45° FOV: 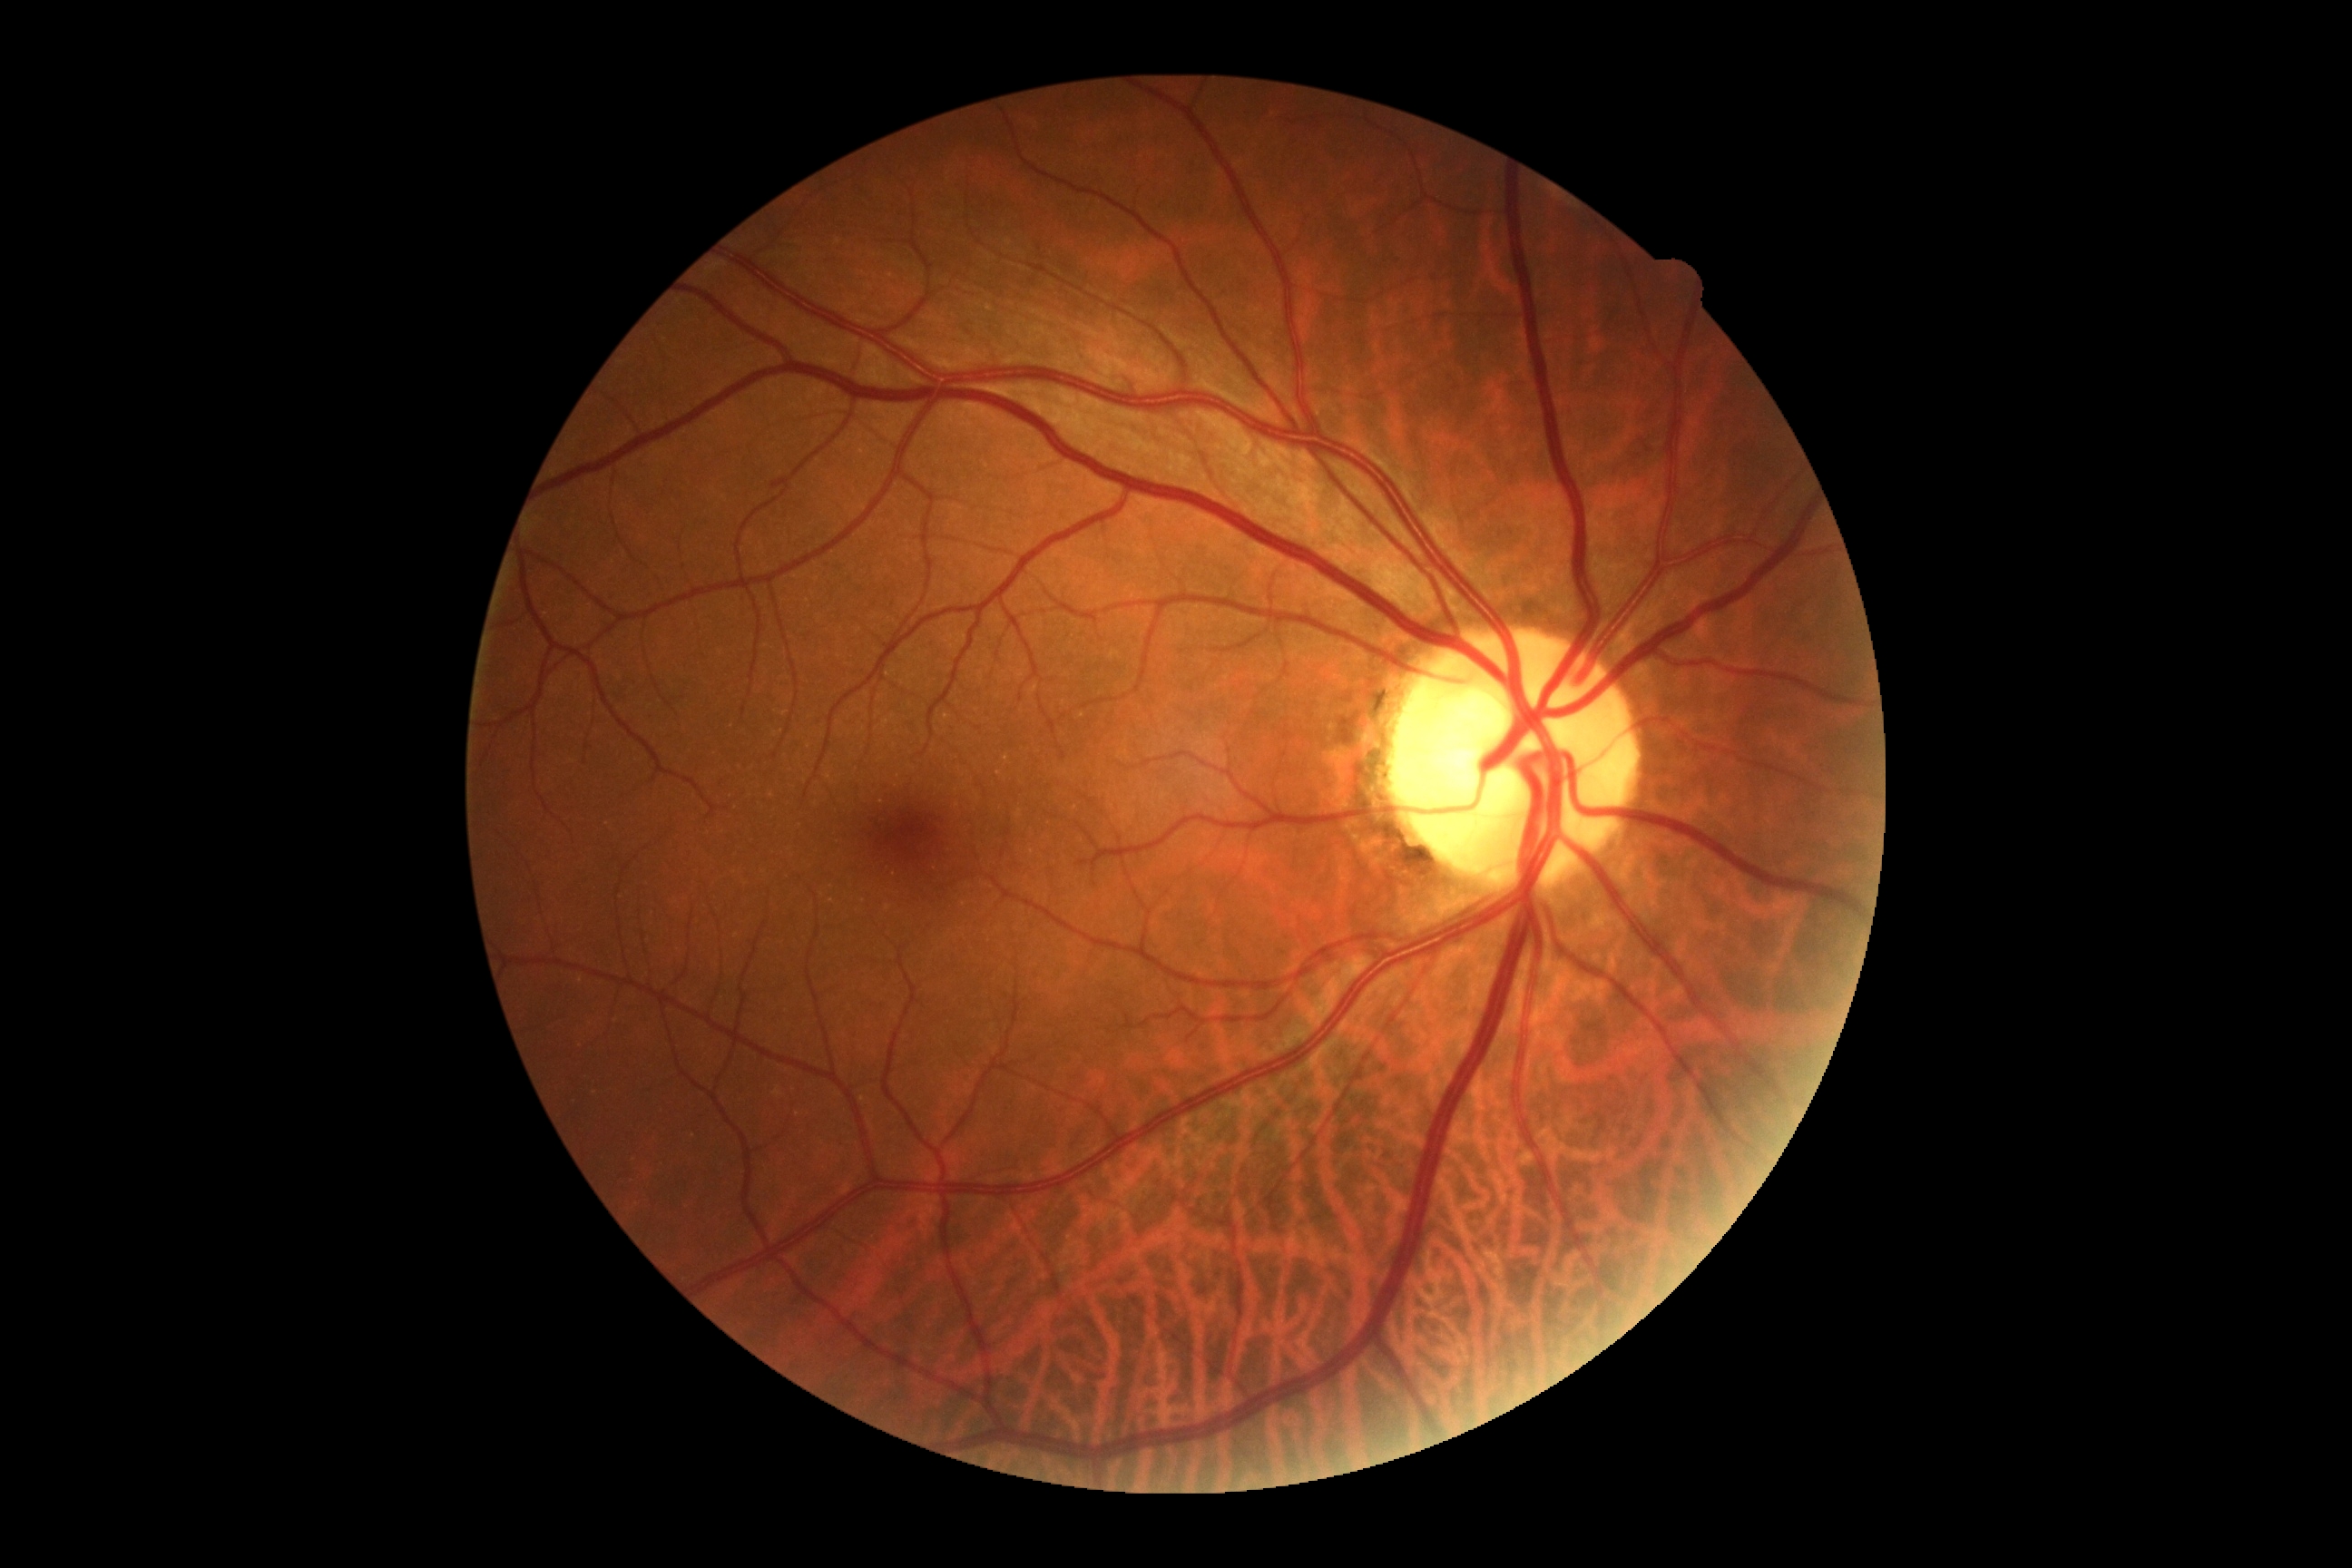 No DR findings. DR stage: 0.